Acquired with a NIDEK AFC-230; no pharmacologic dilation: 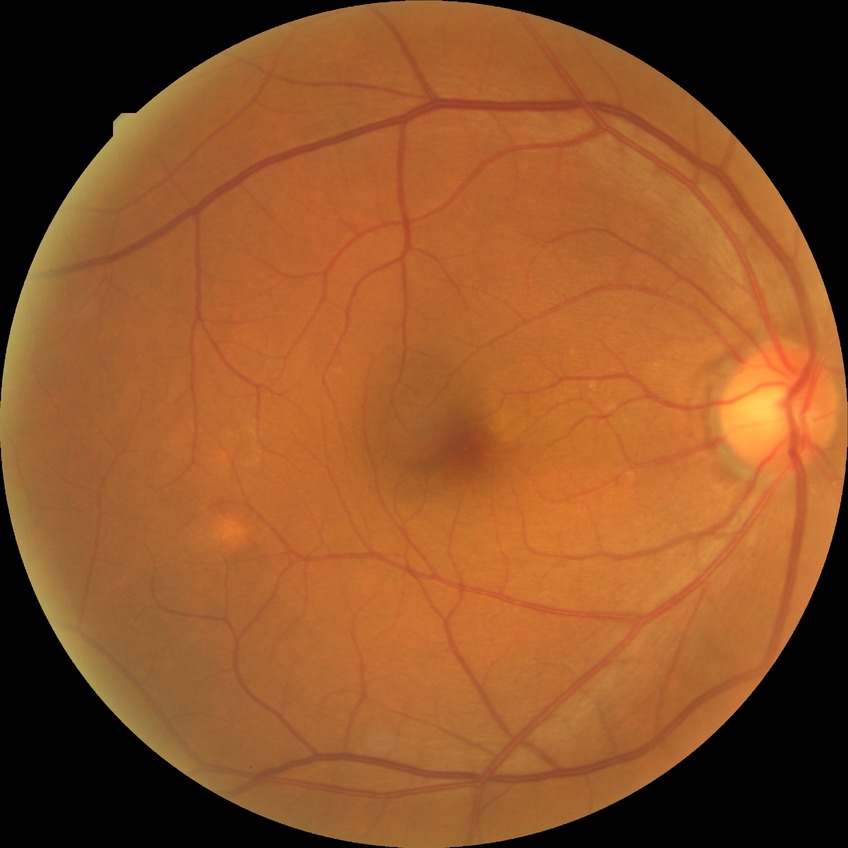

Diabetic retinopathy (DR): no diabetic retinopathy (NDR).